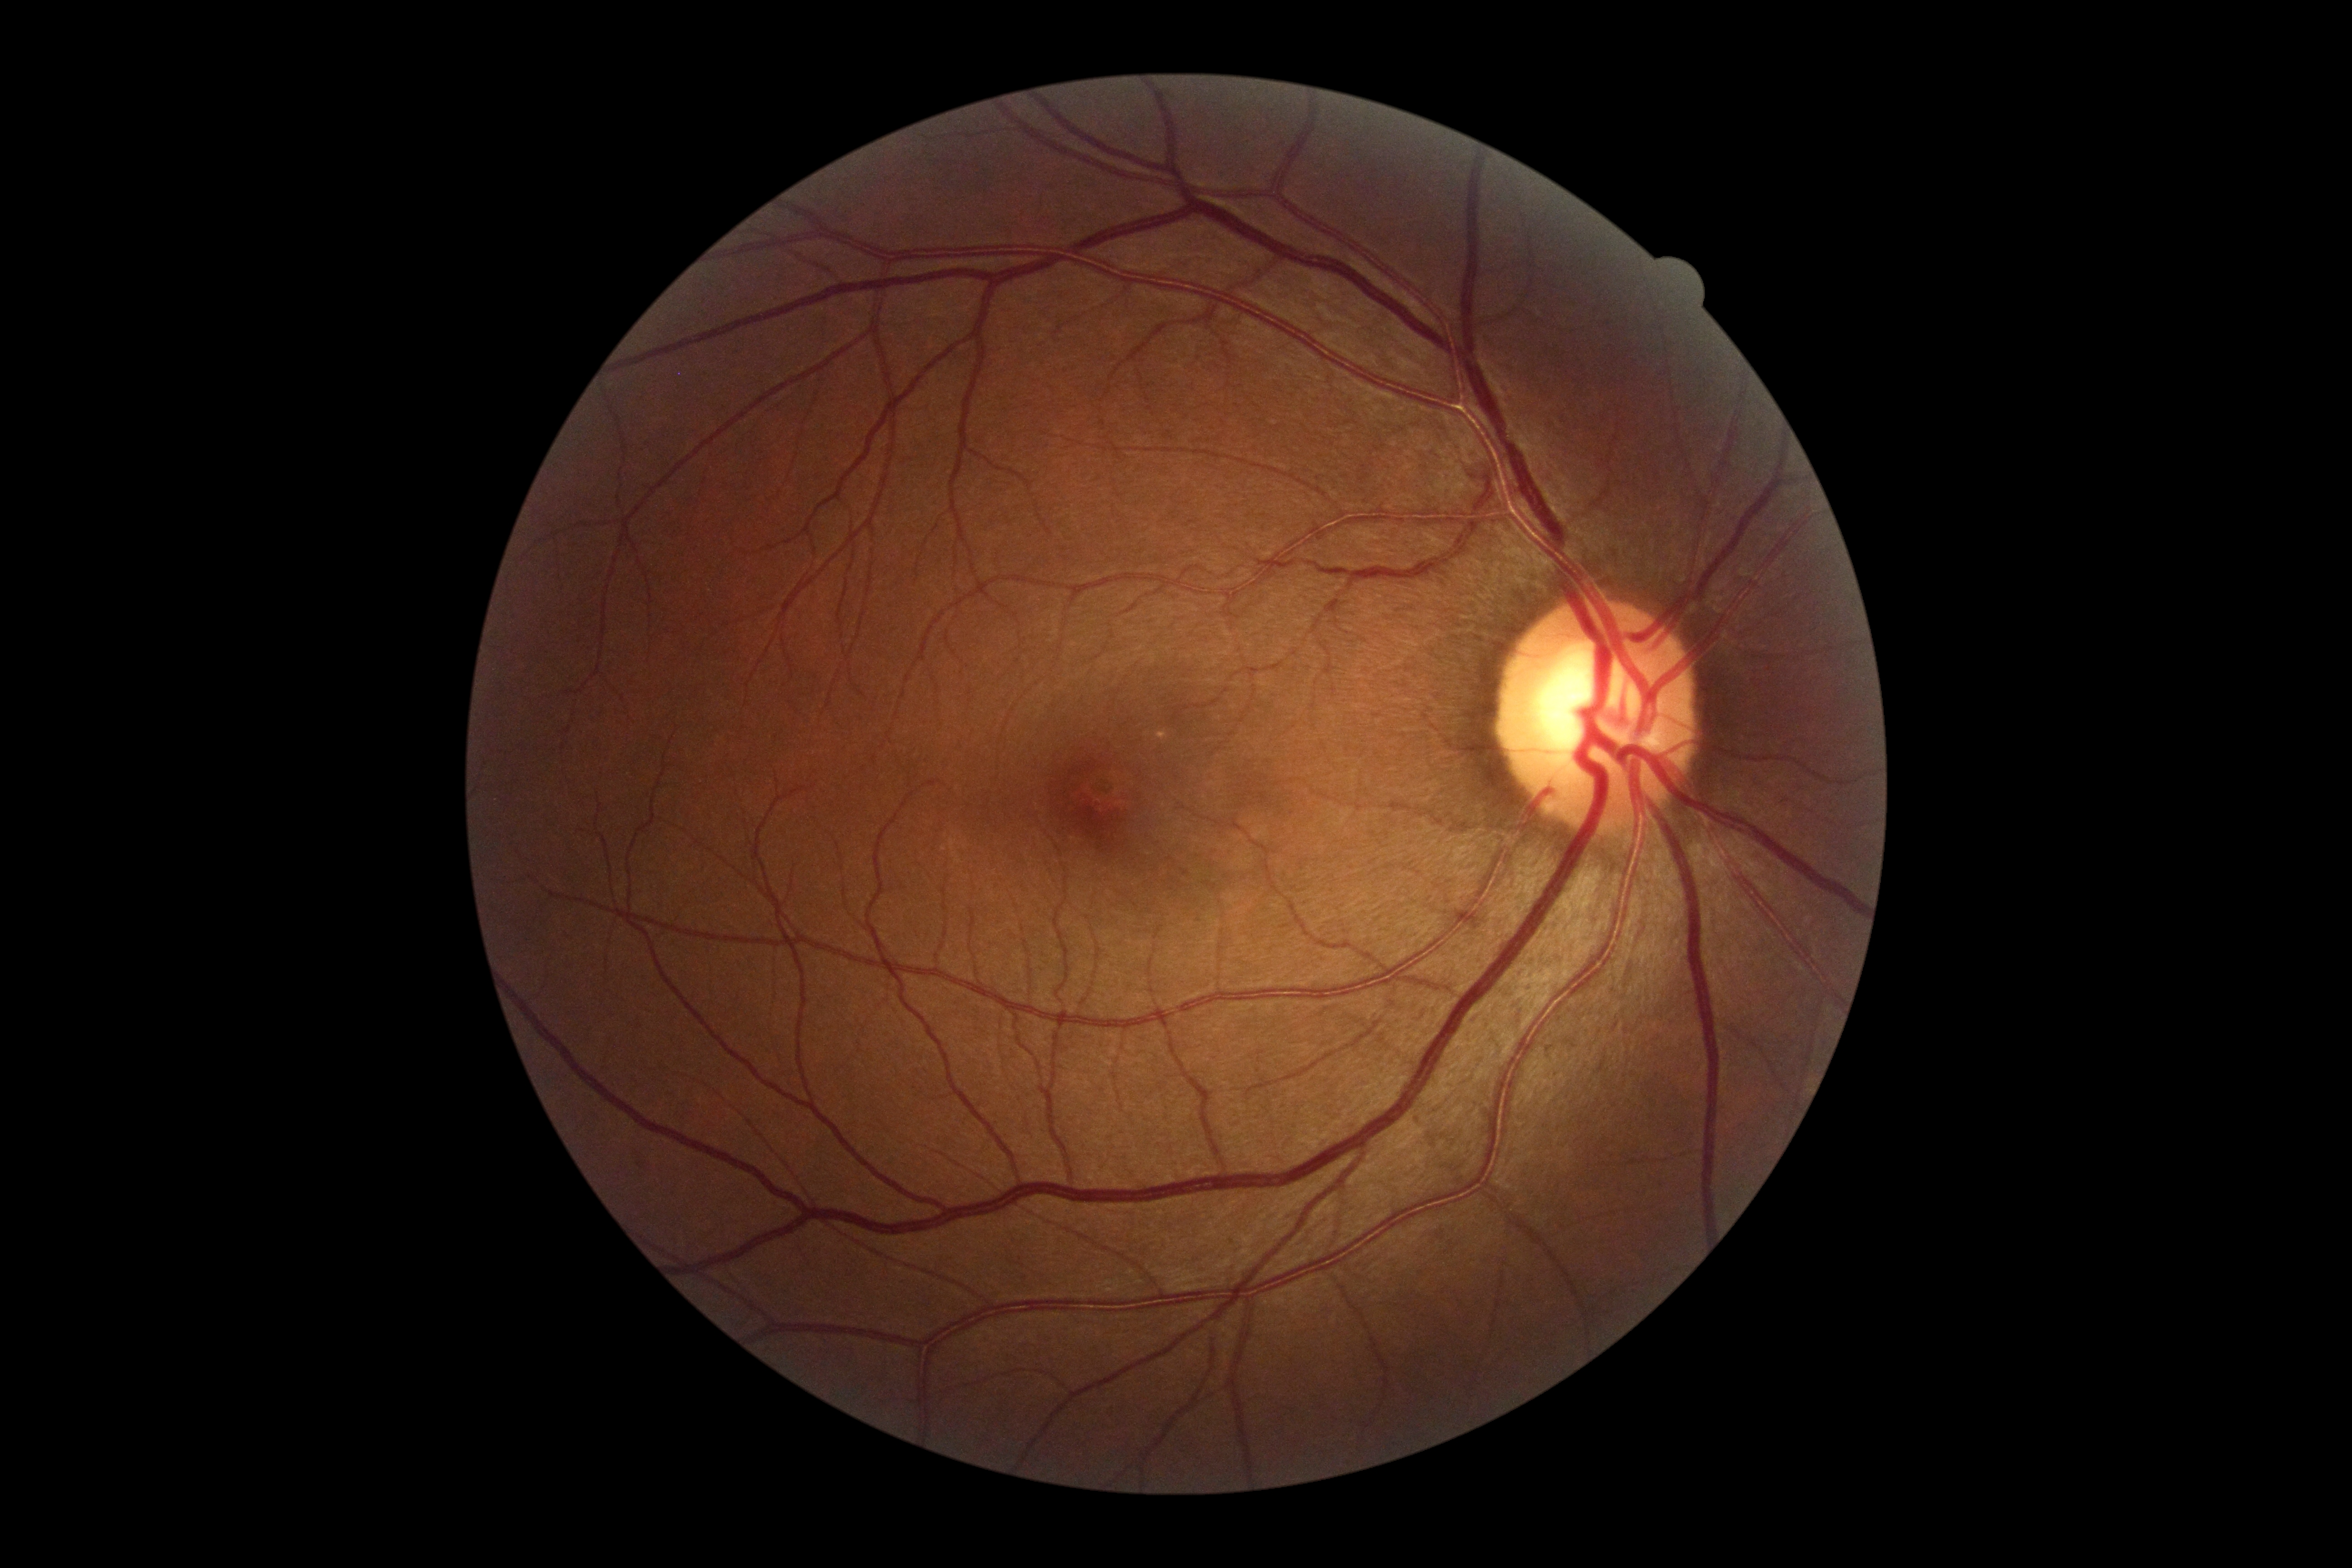

DR stage: grade 0, DR impression: no DR findings.